Modified Davis classification · NIDEK AFC-230 fundus camera — 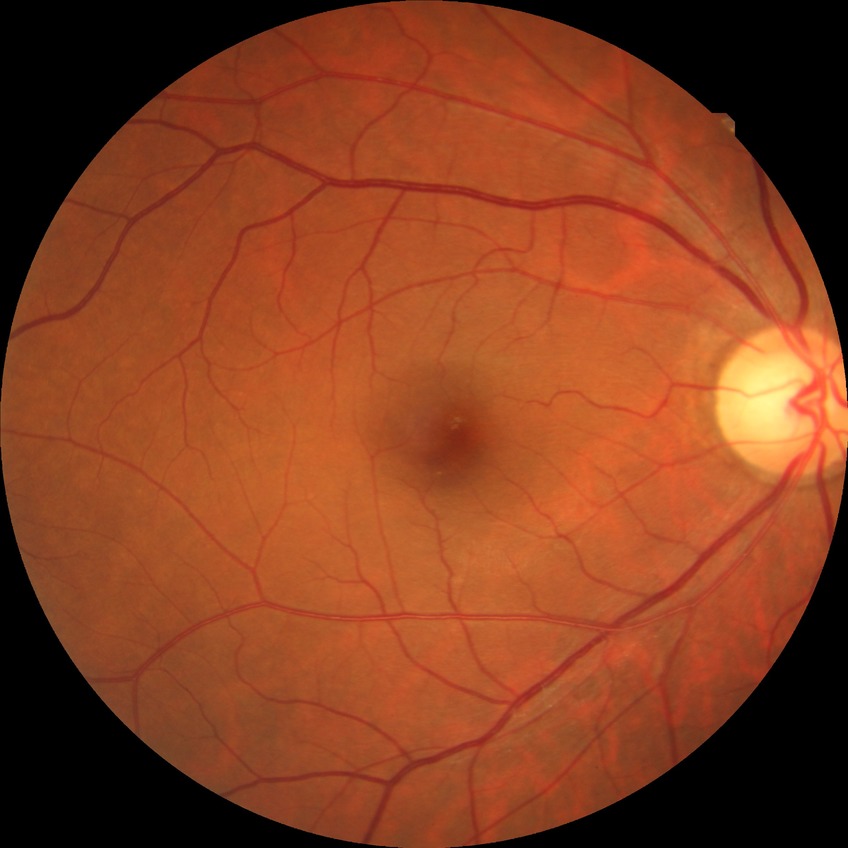
Retinopathy stage: no diabetic retinopathy.